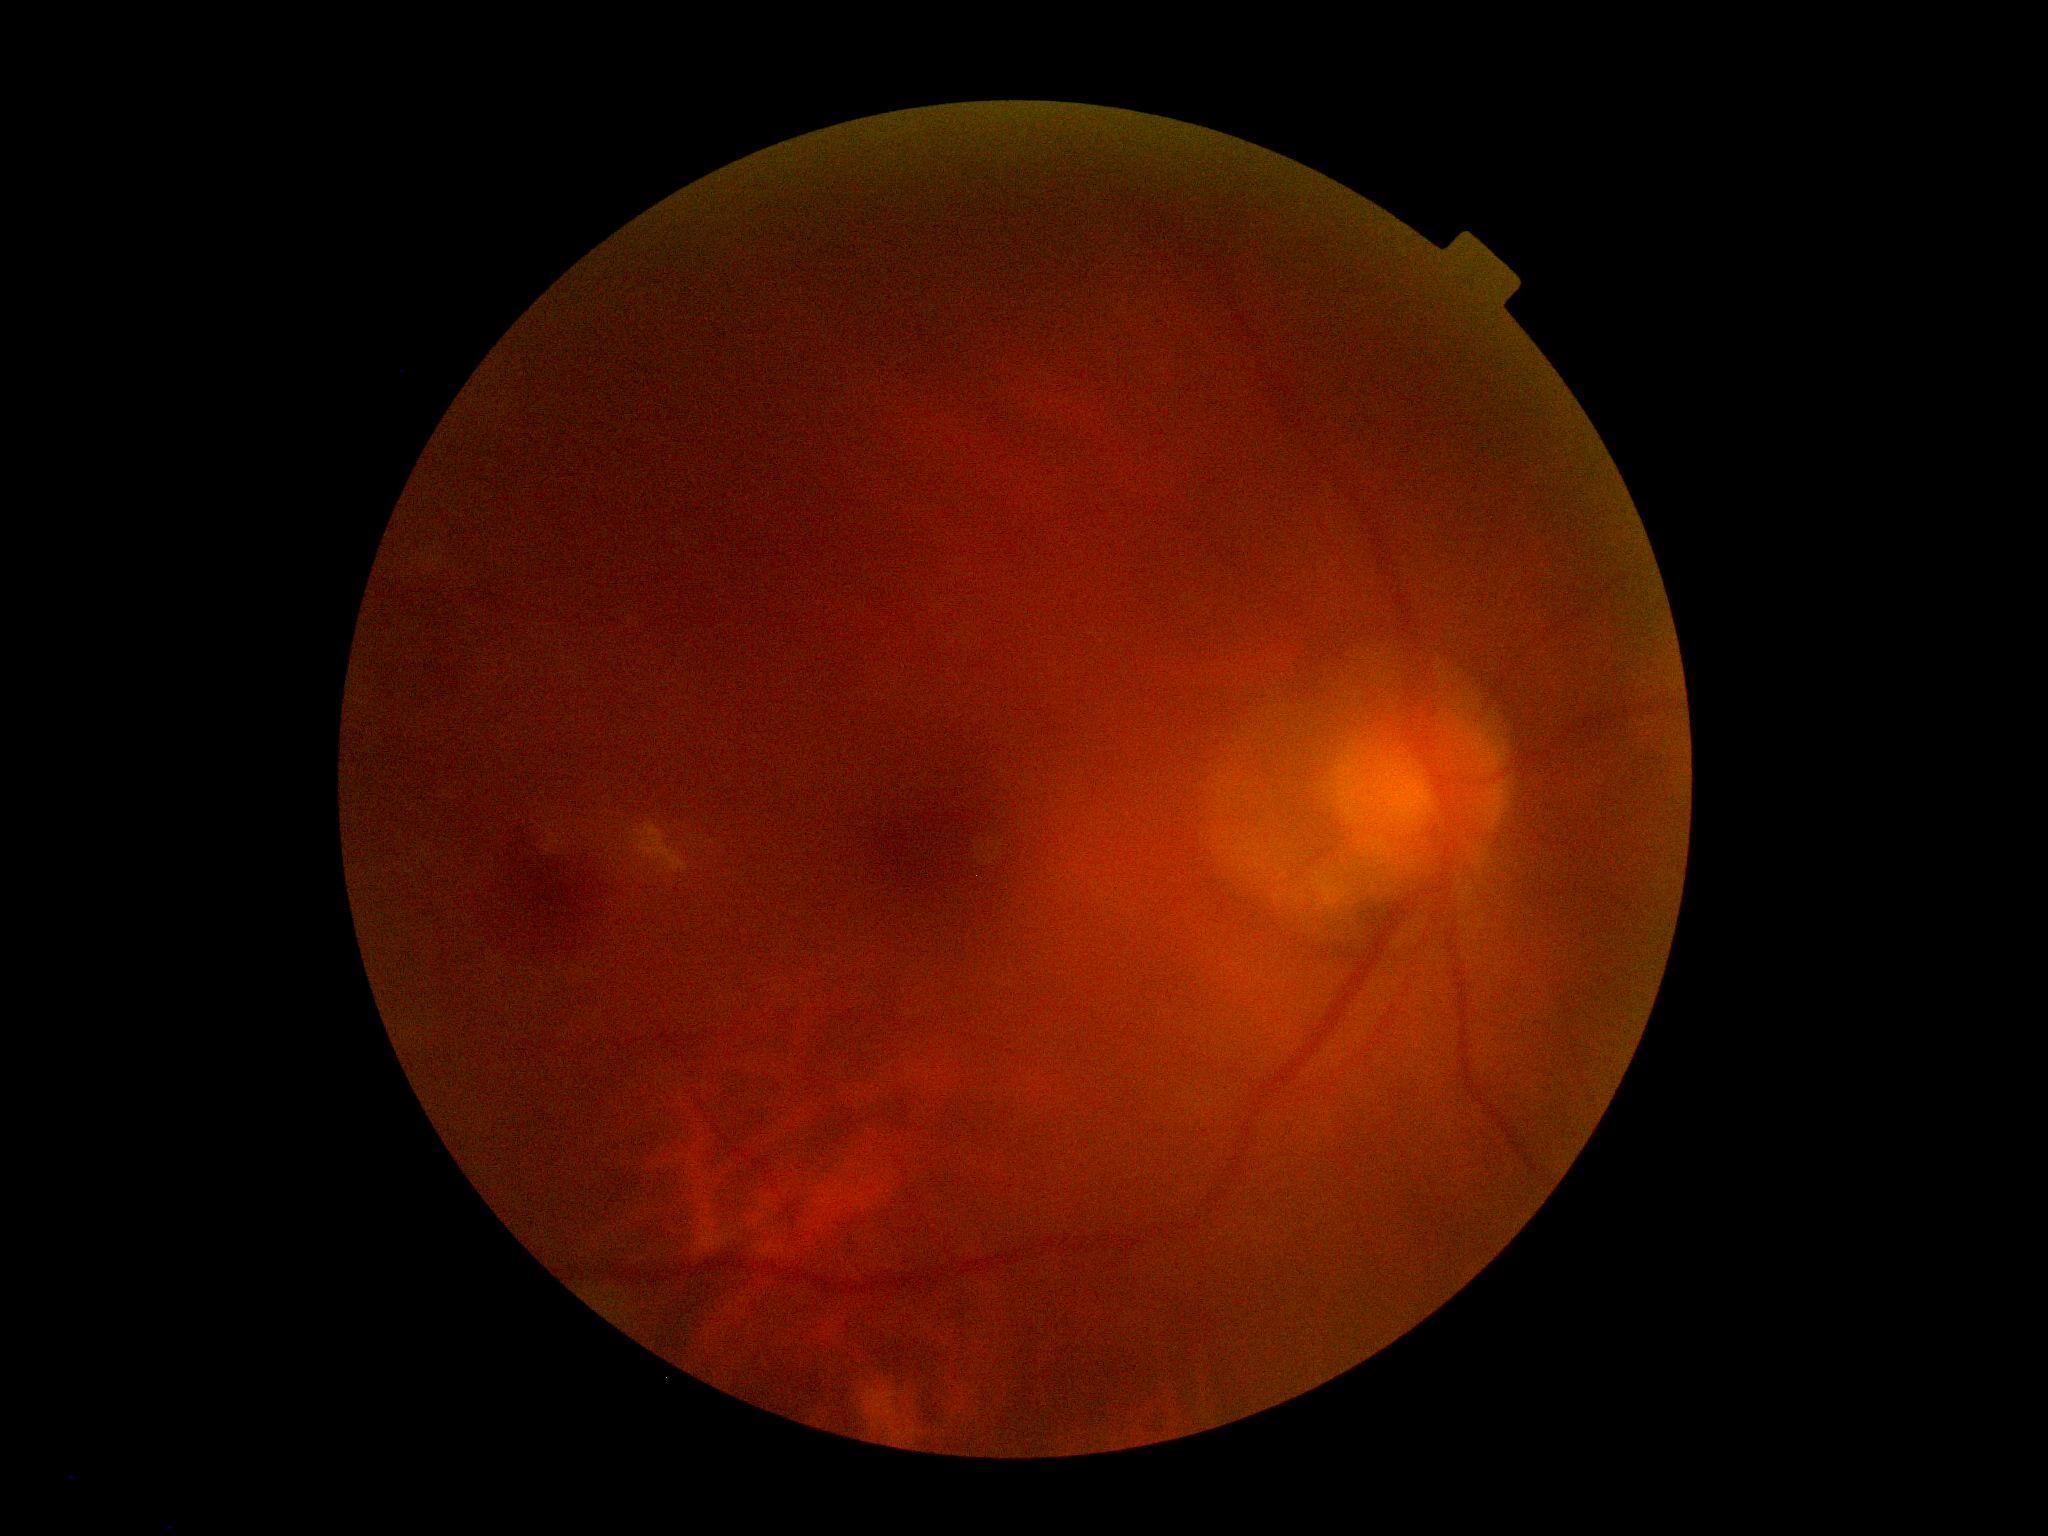 retinopathy grade: ungradable due to poor image quality | image quality: insufficient.